Nonmydriatic, 45° FOV, color fundus image.
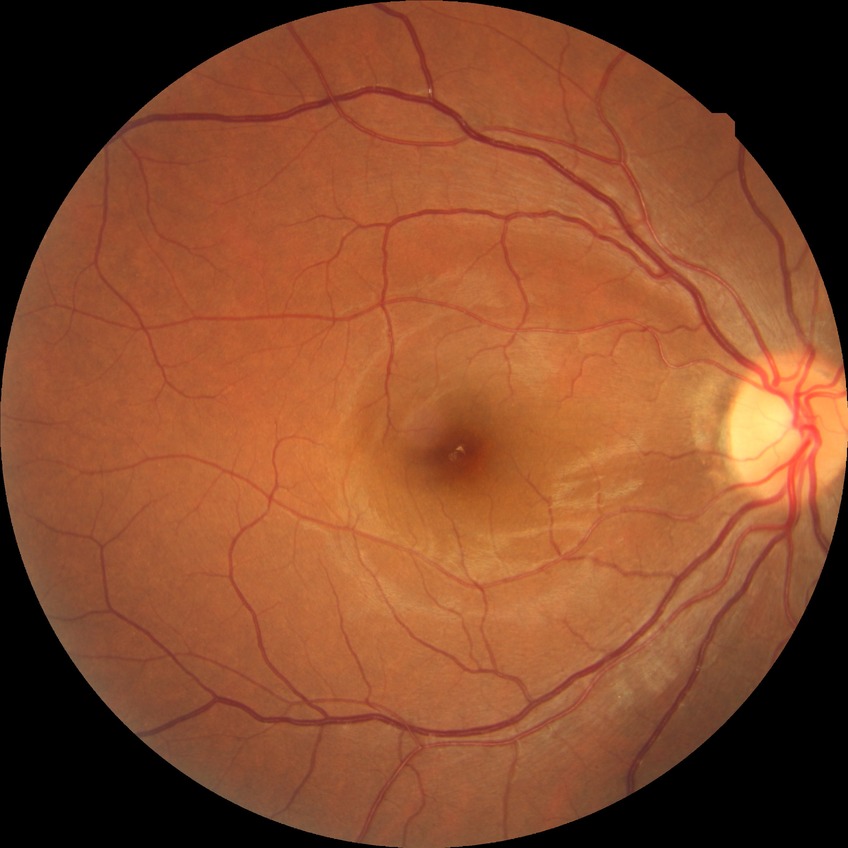

{
  "davis_grade": "simple diabetic retinopathy"
}